Graded on the modified Davis scale; posterior pole color fundus photograph; 848x848px: 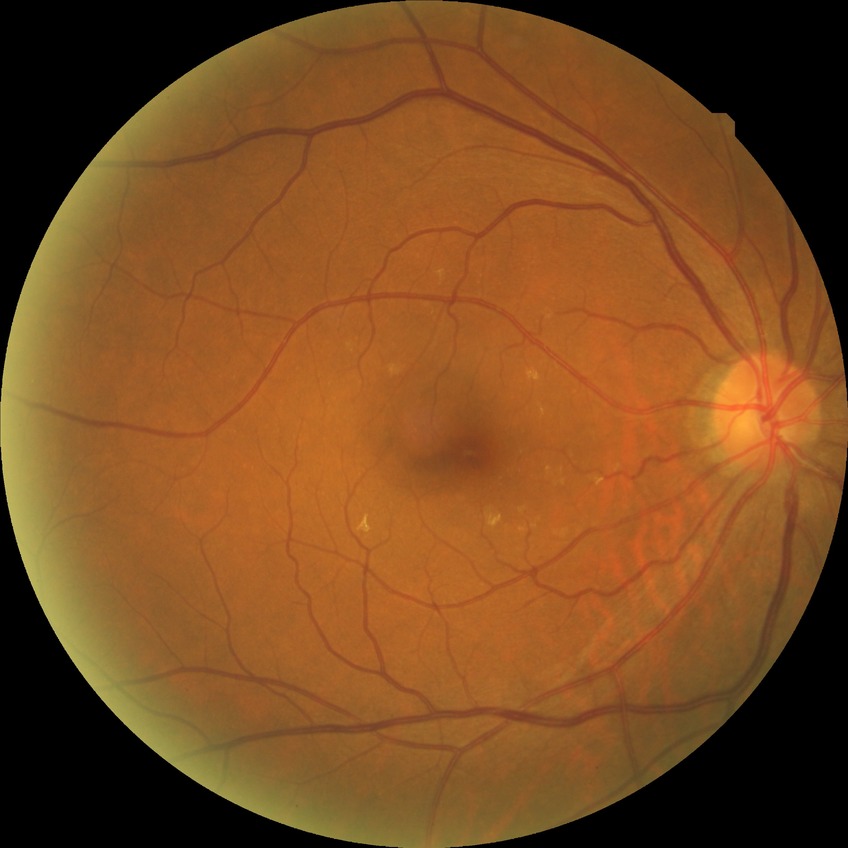
Diabetic retinopathy (DR) is NDR (no diabetic retinopathy).